Color fundus photograph; 512 by 512 pixels: 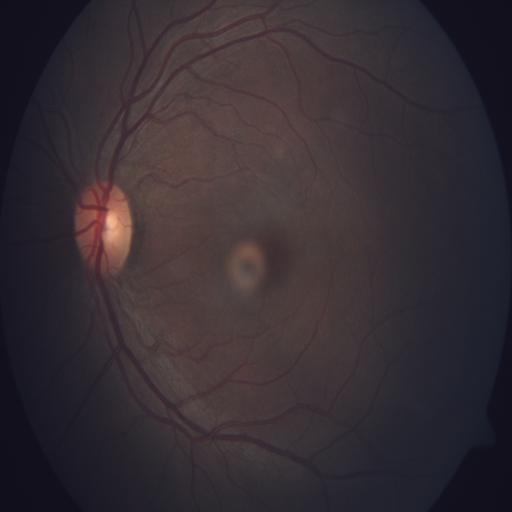 The fundus appears normal with no pathological findings.